Color fundus image · 2352x1568px:
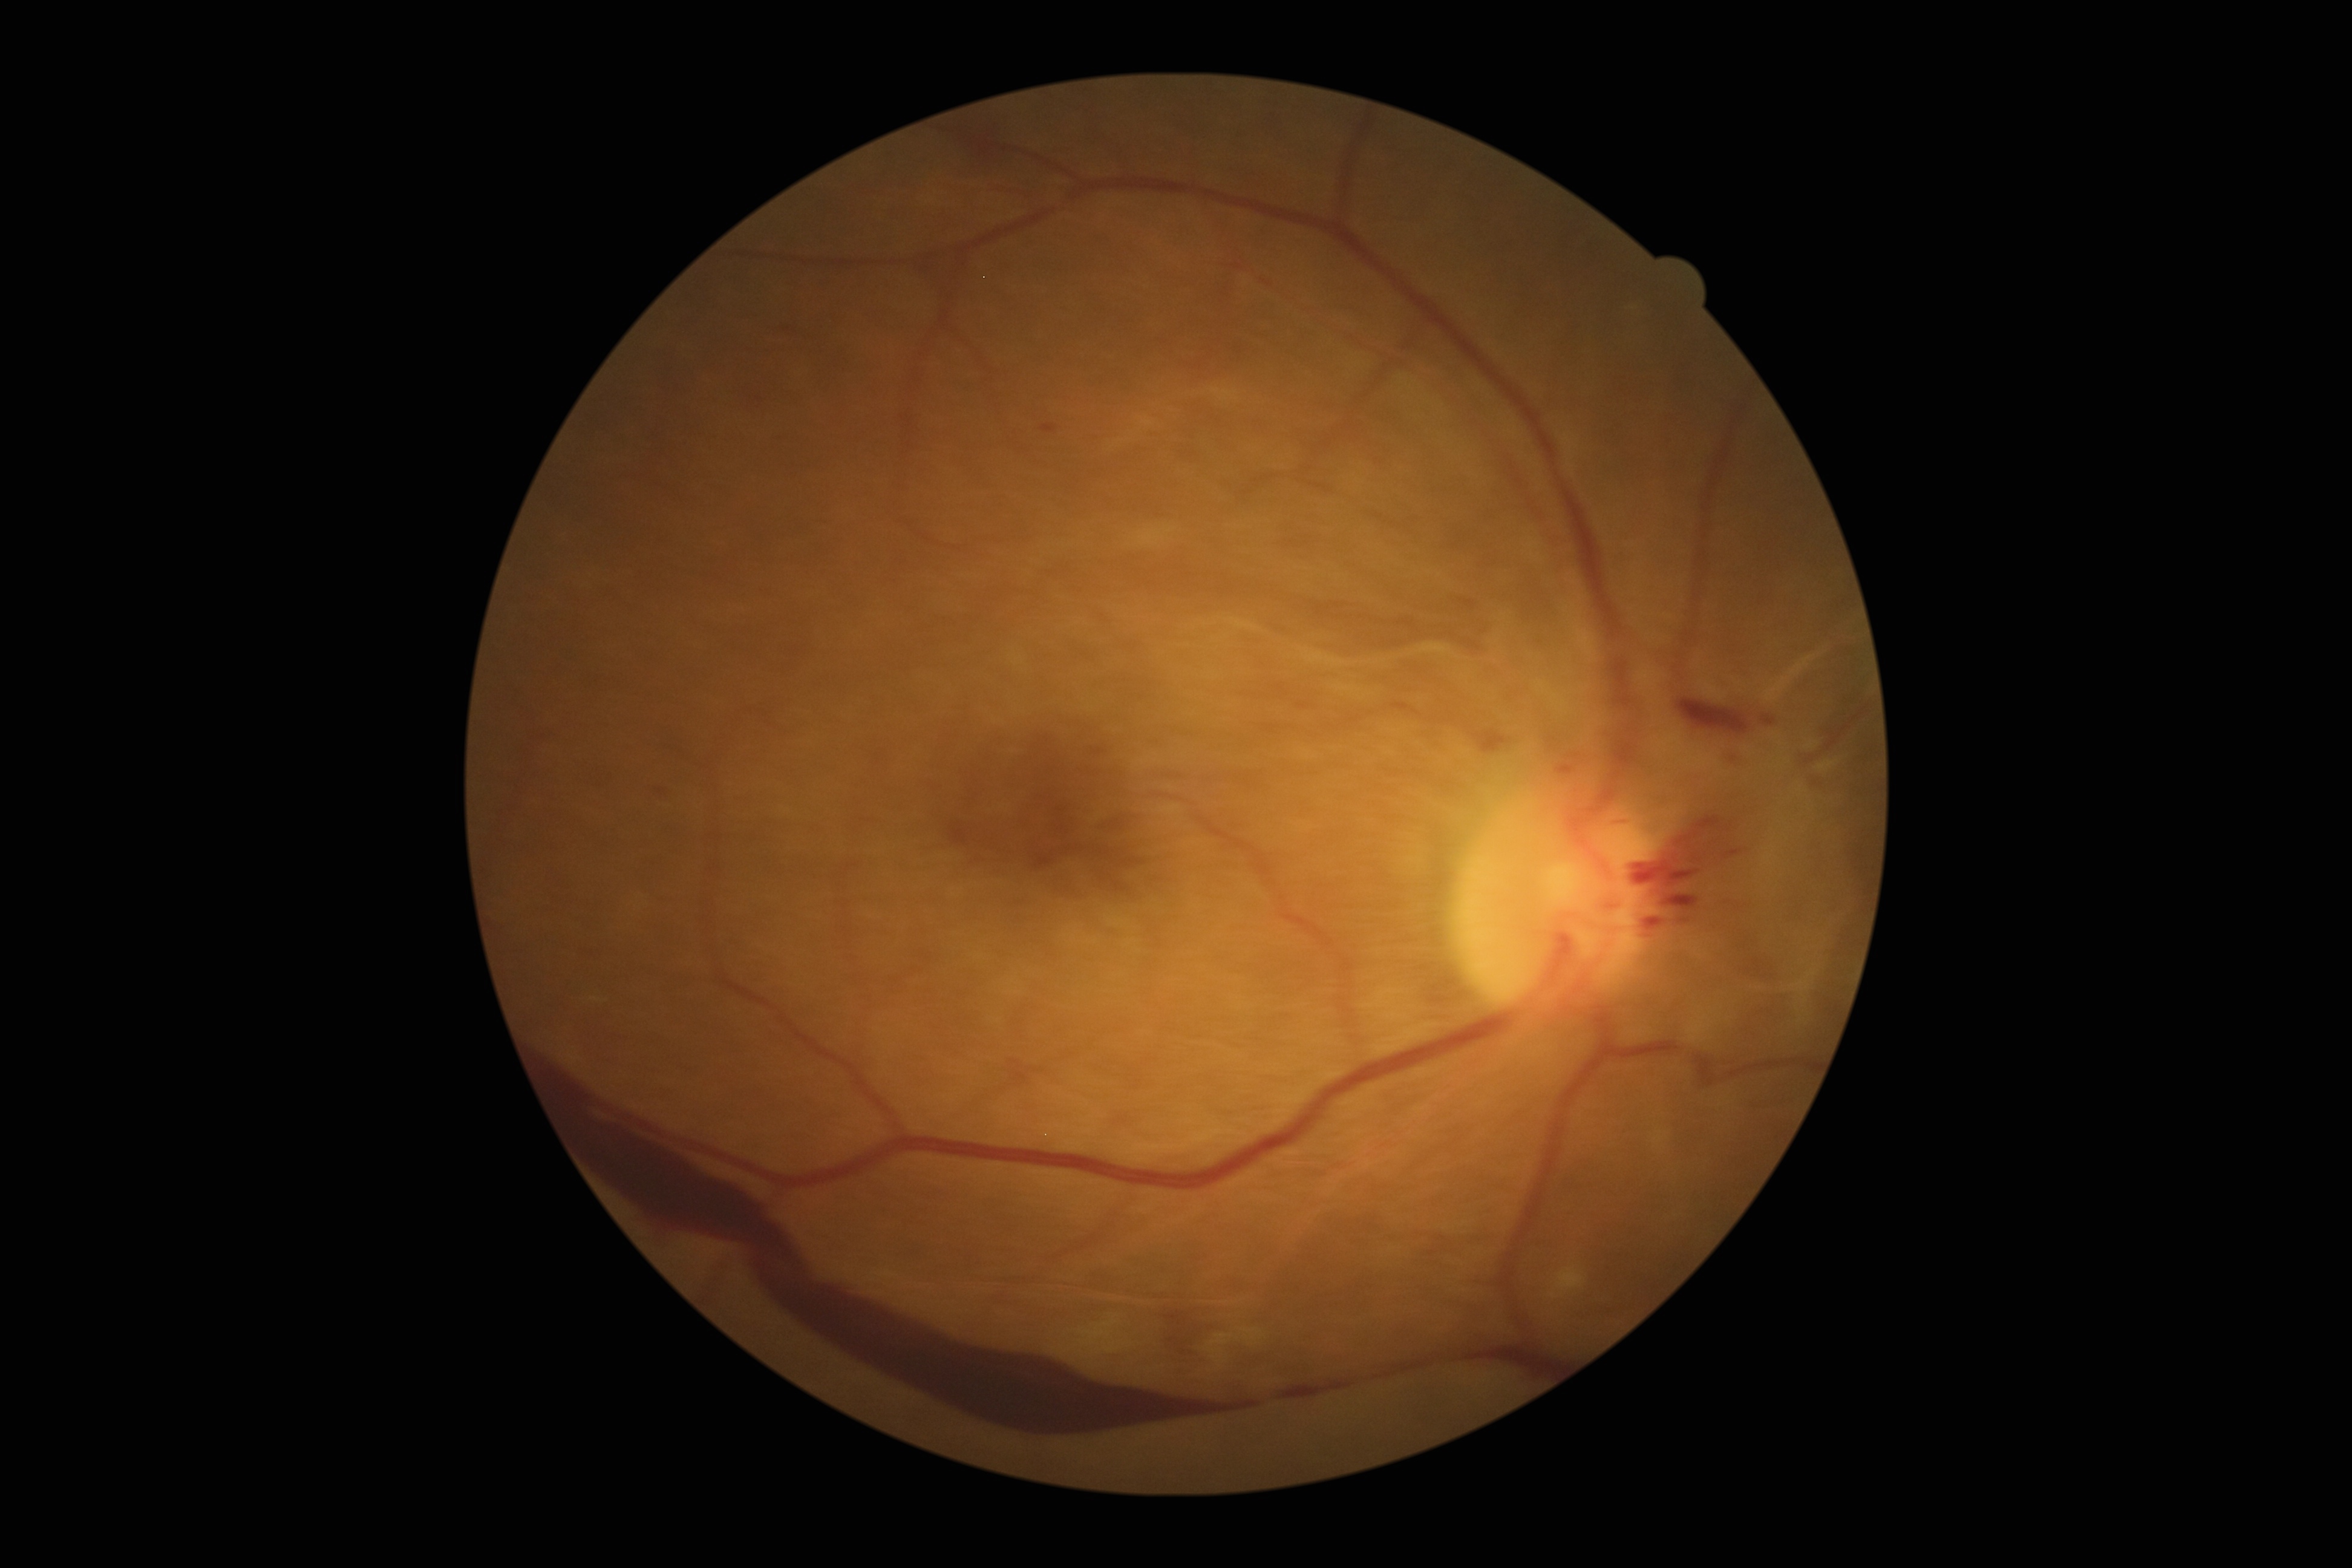

Annotations:
• diabetic retinopathy (DR) — grade 4